240x240; captured without pupil dilation; captured on a Nidek AFC-330 fundus camera
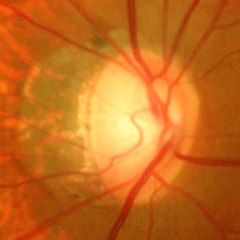
Assessment = advanced glaucoma. Defined as near-total cupping of the optic nerve head, with or without severe visual field loss within the central 10 degrees of fixation.